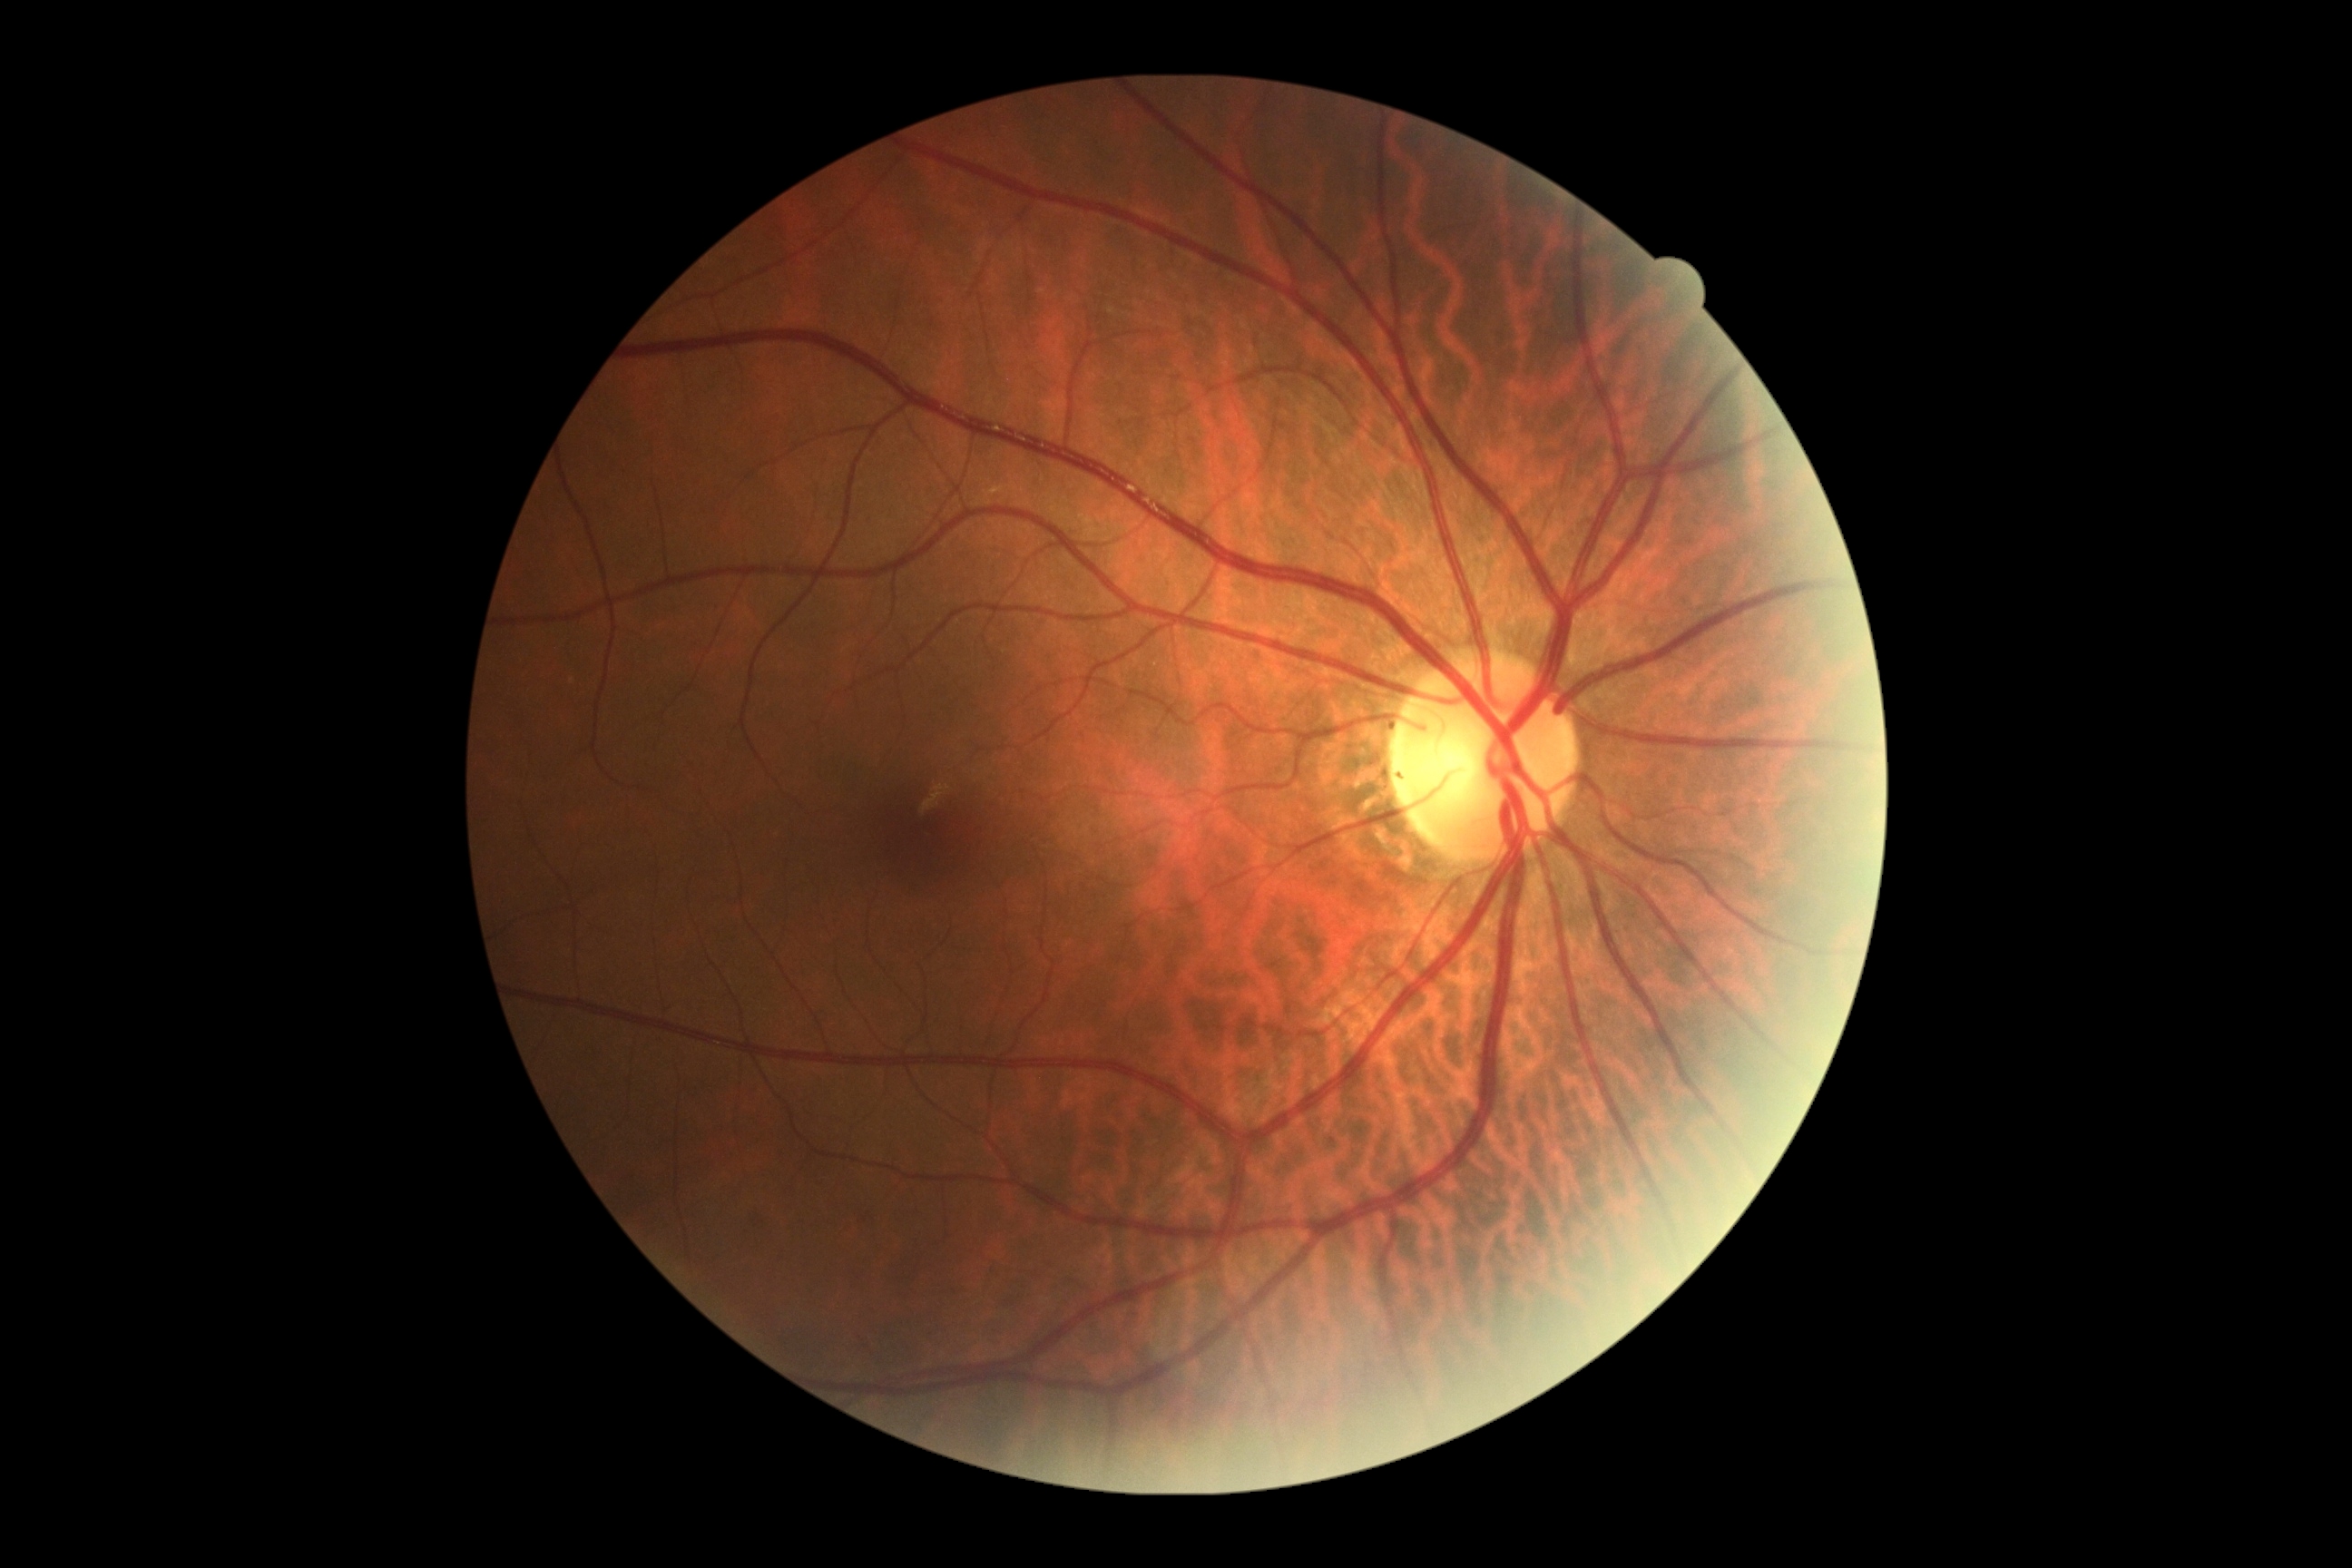 Diabetic retinopathy grade is 0 (no apparent retinopathy).